Davis DR grading.
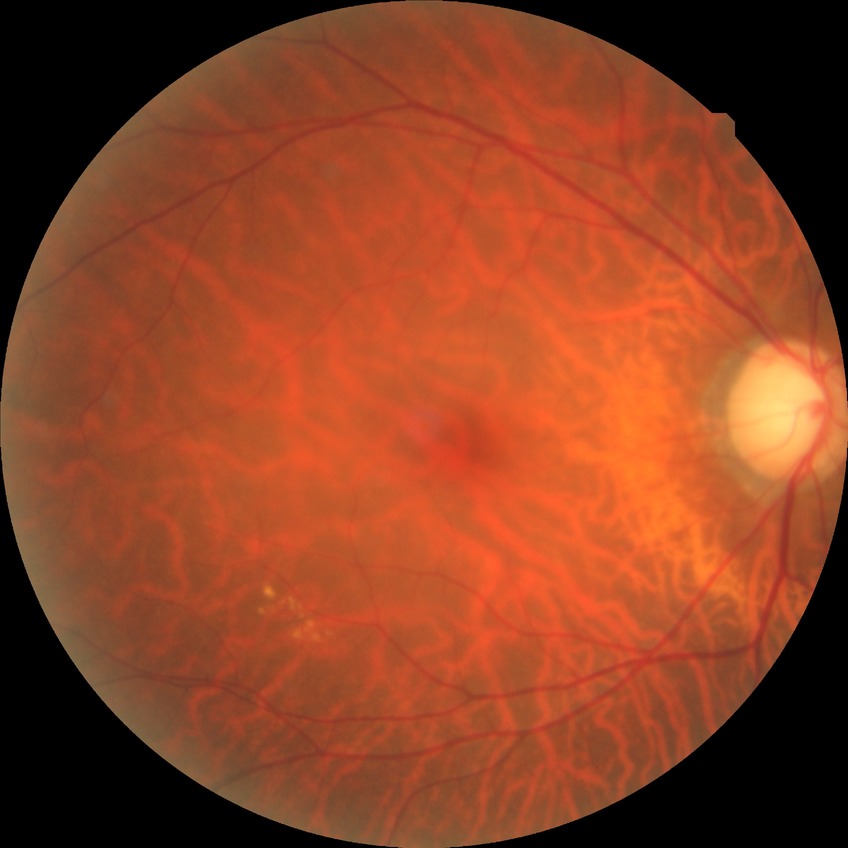 • retinopathy grade — no diabetic retinopathy